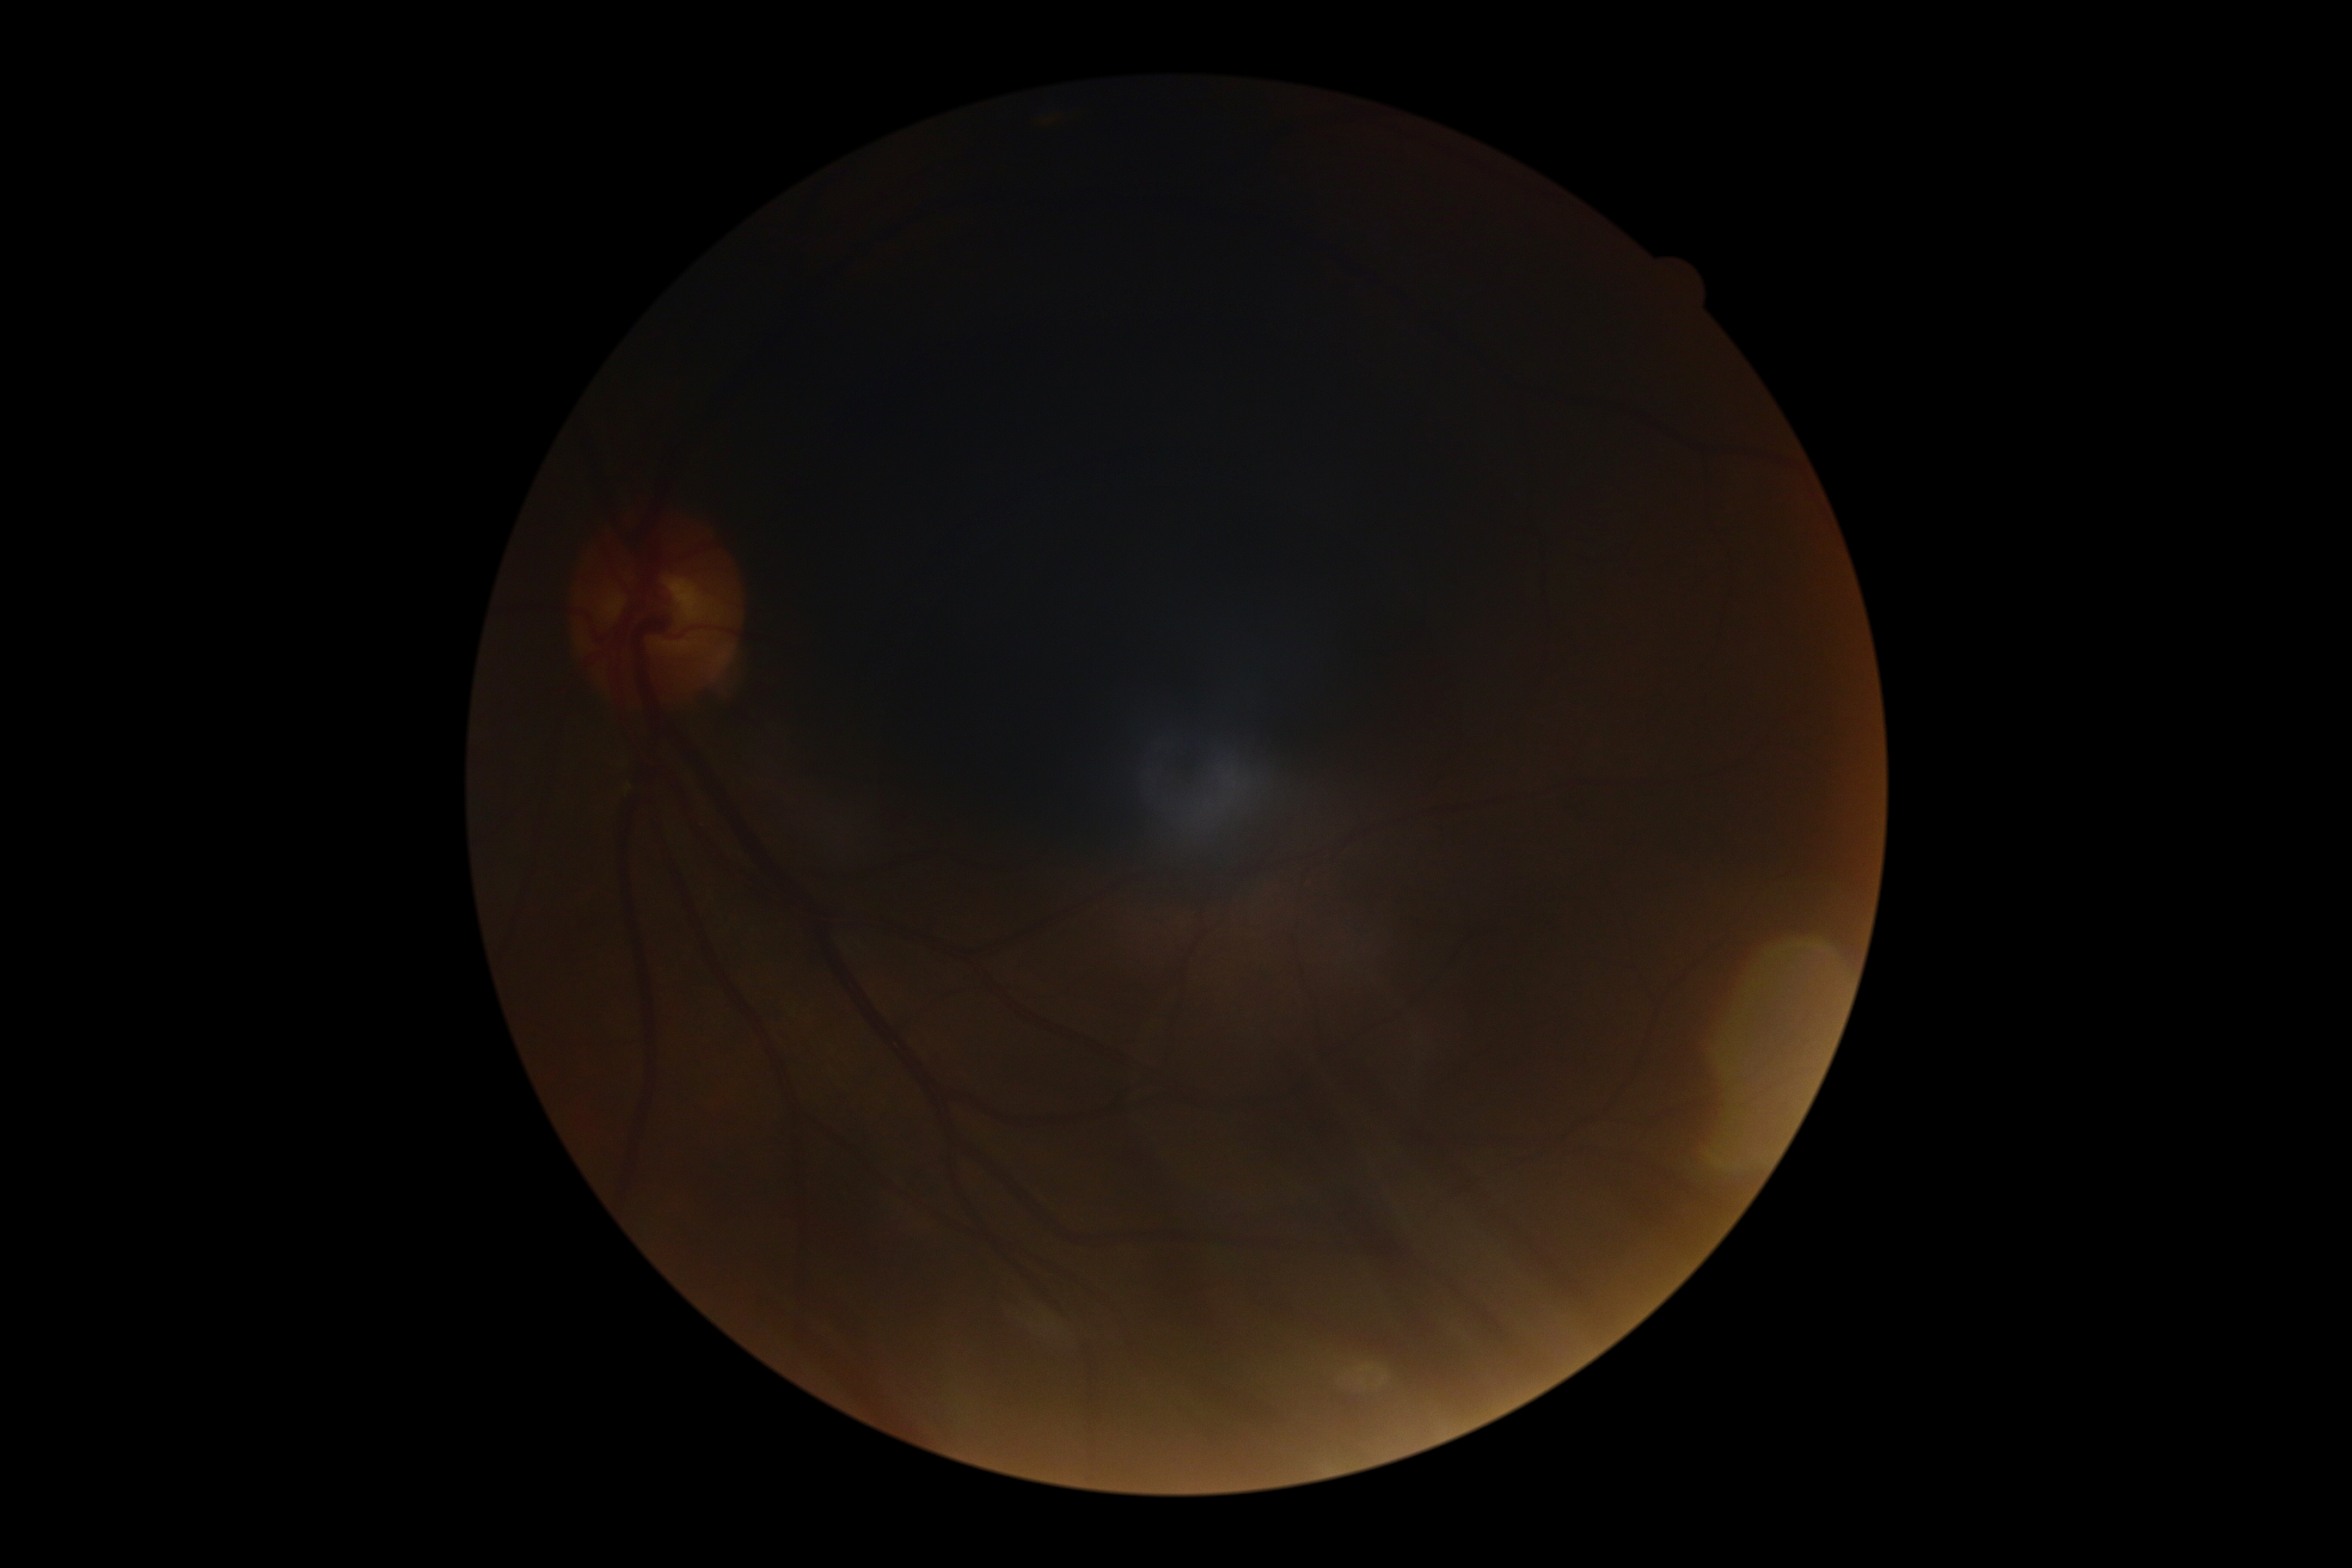 DR grade: ungradable due to poor image quality.